Image size 2212x1659; 45° FOV; retinal fundus photograph.
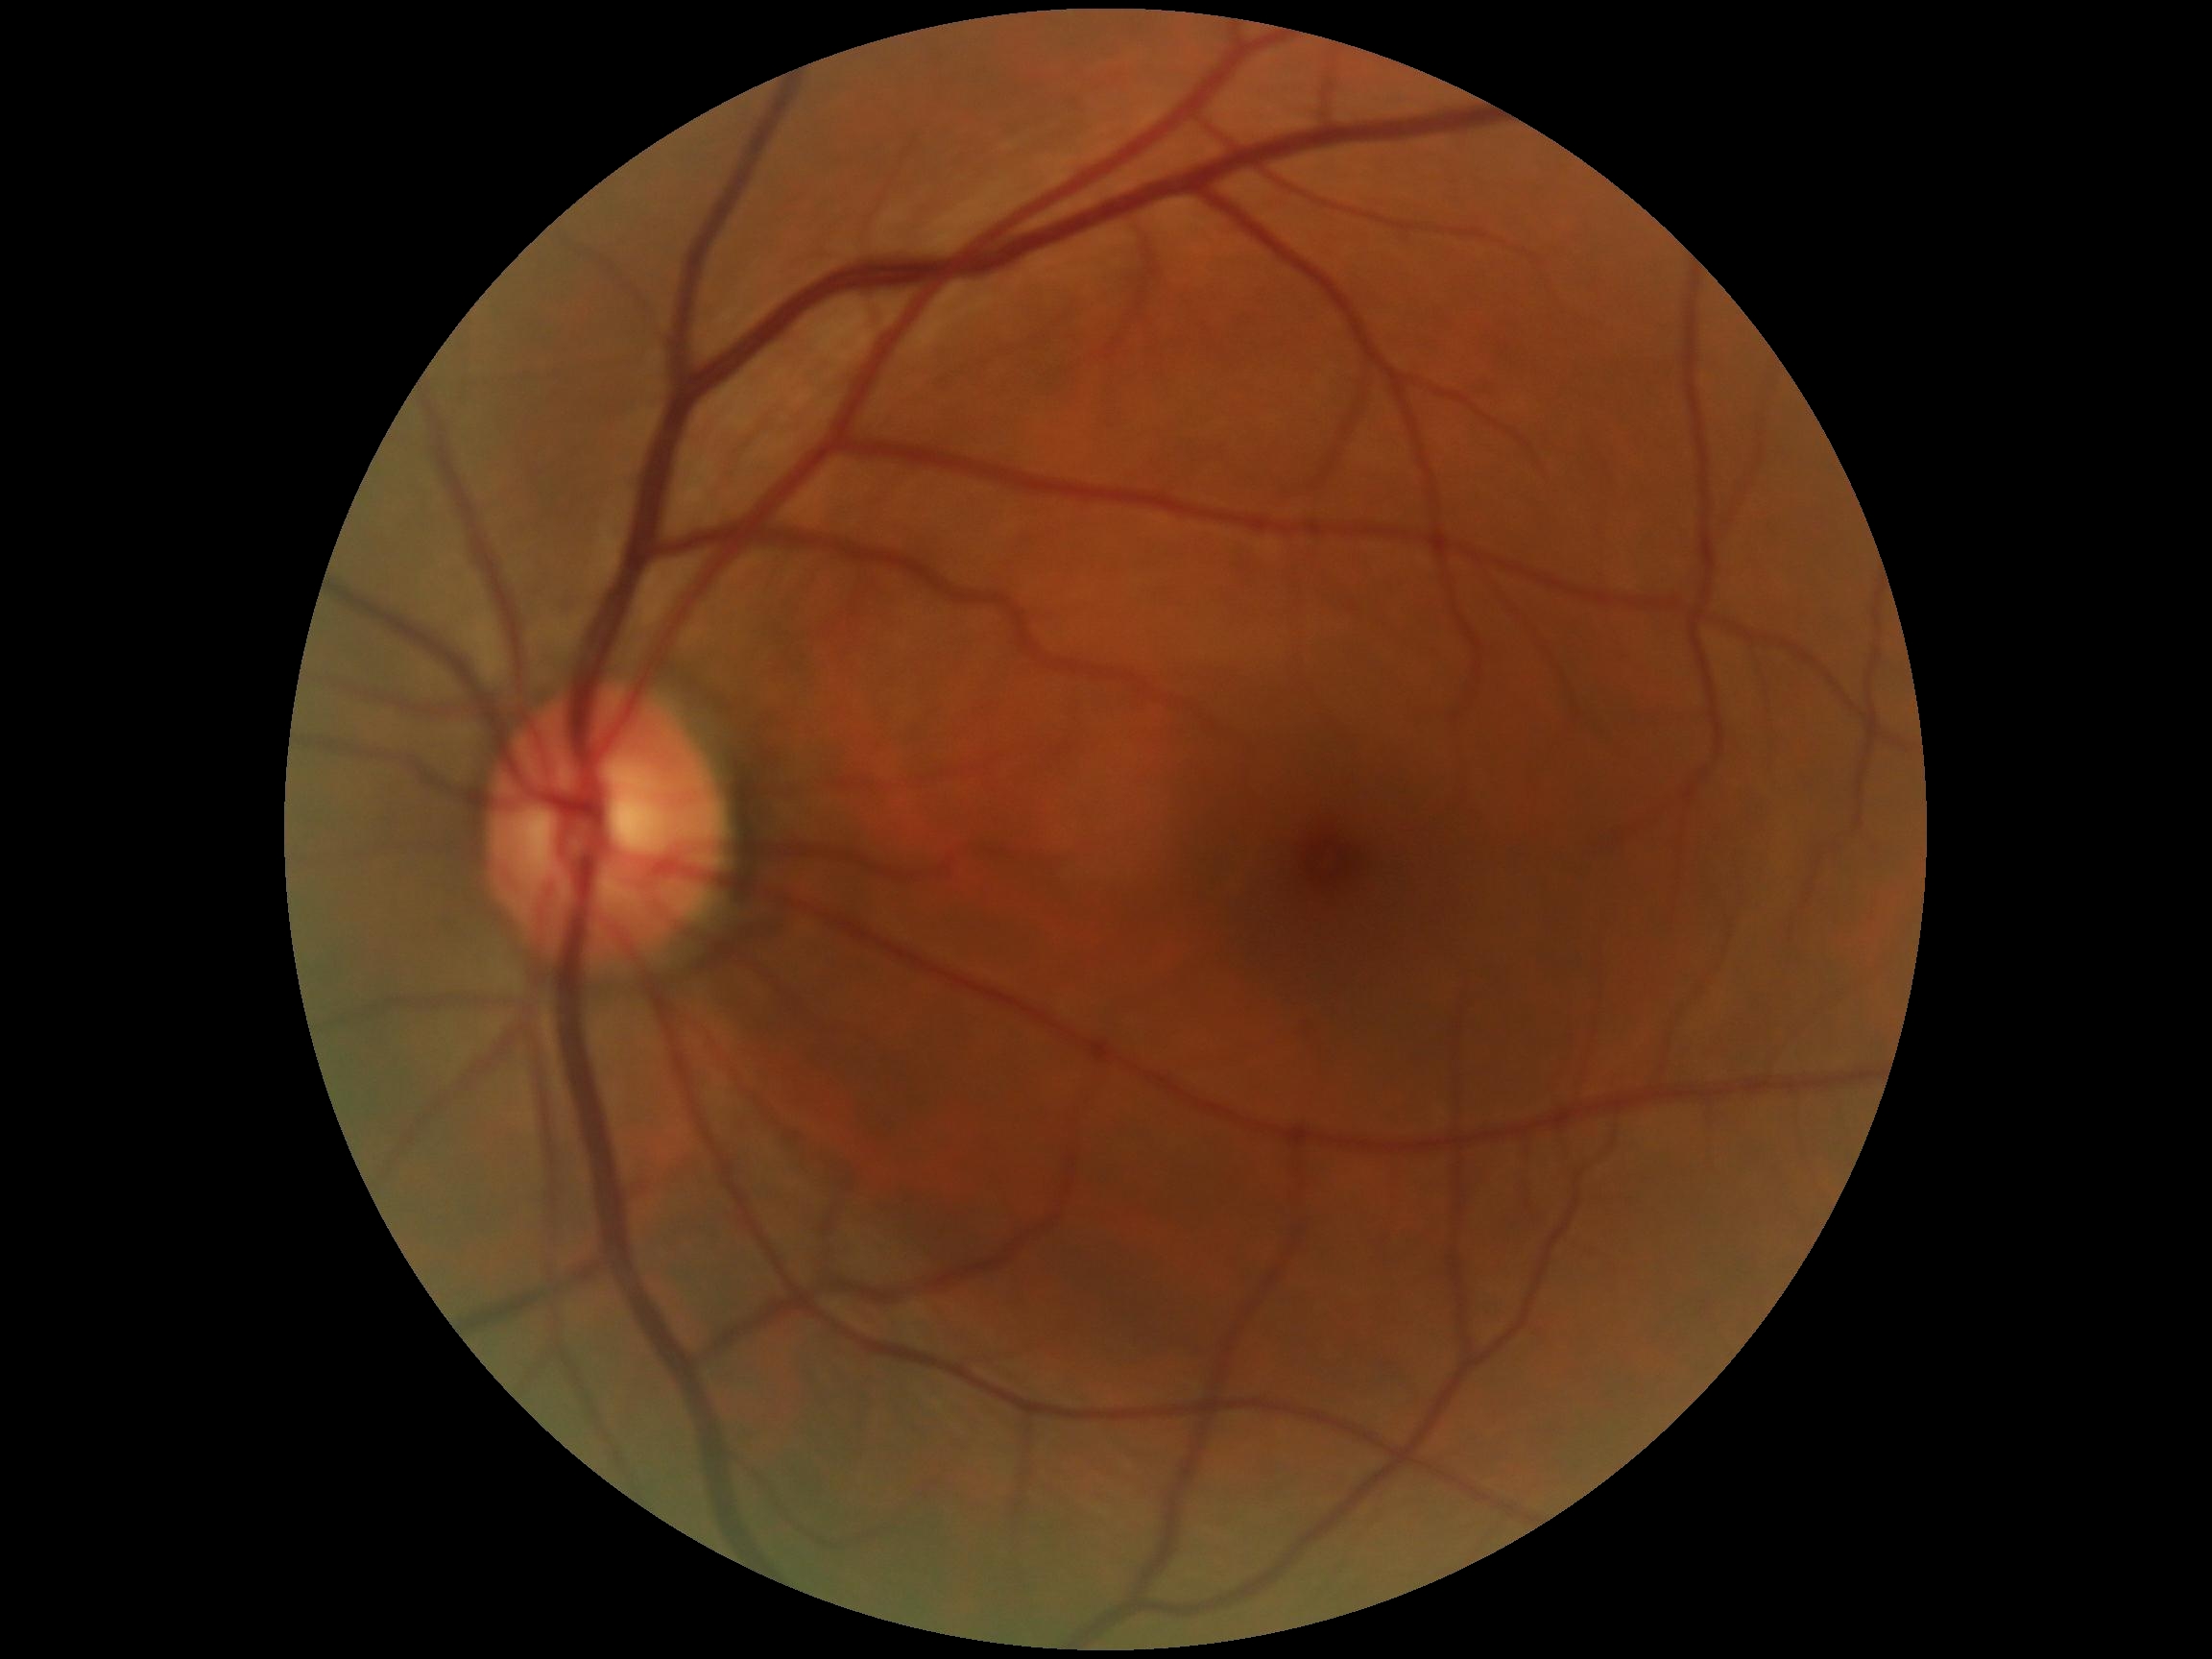
diabetic retinopathy (DR)=grade 0 (no apparent retinopathy).